Acquired with a Nidek AFC-330.
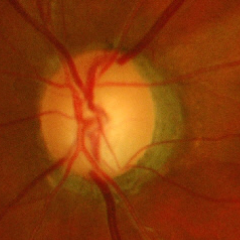
Optic nerve head appearance consistent with advanced glaucoma. (Criteria: near-total cupping of the optic nerve head, with or without severe visual field loss within the central 10 degrees of fixation.)